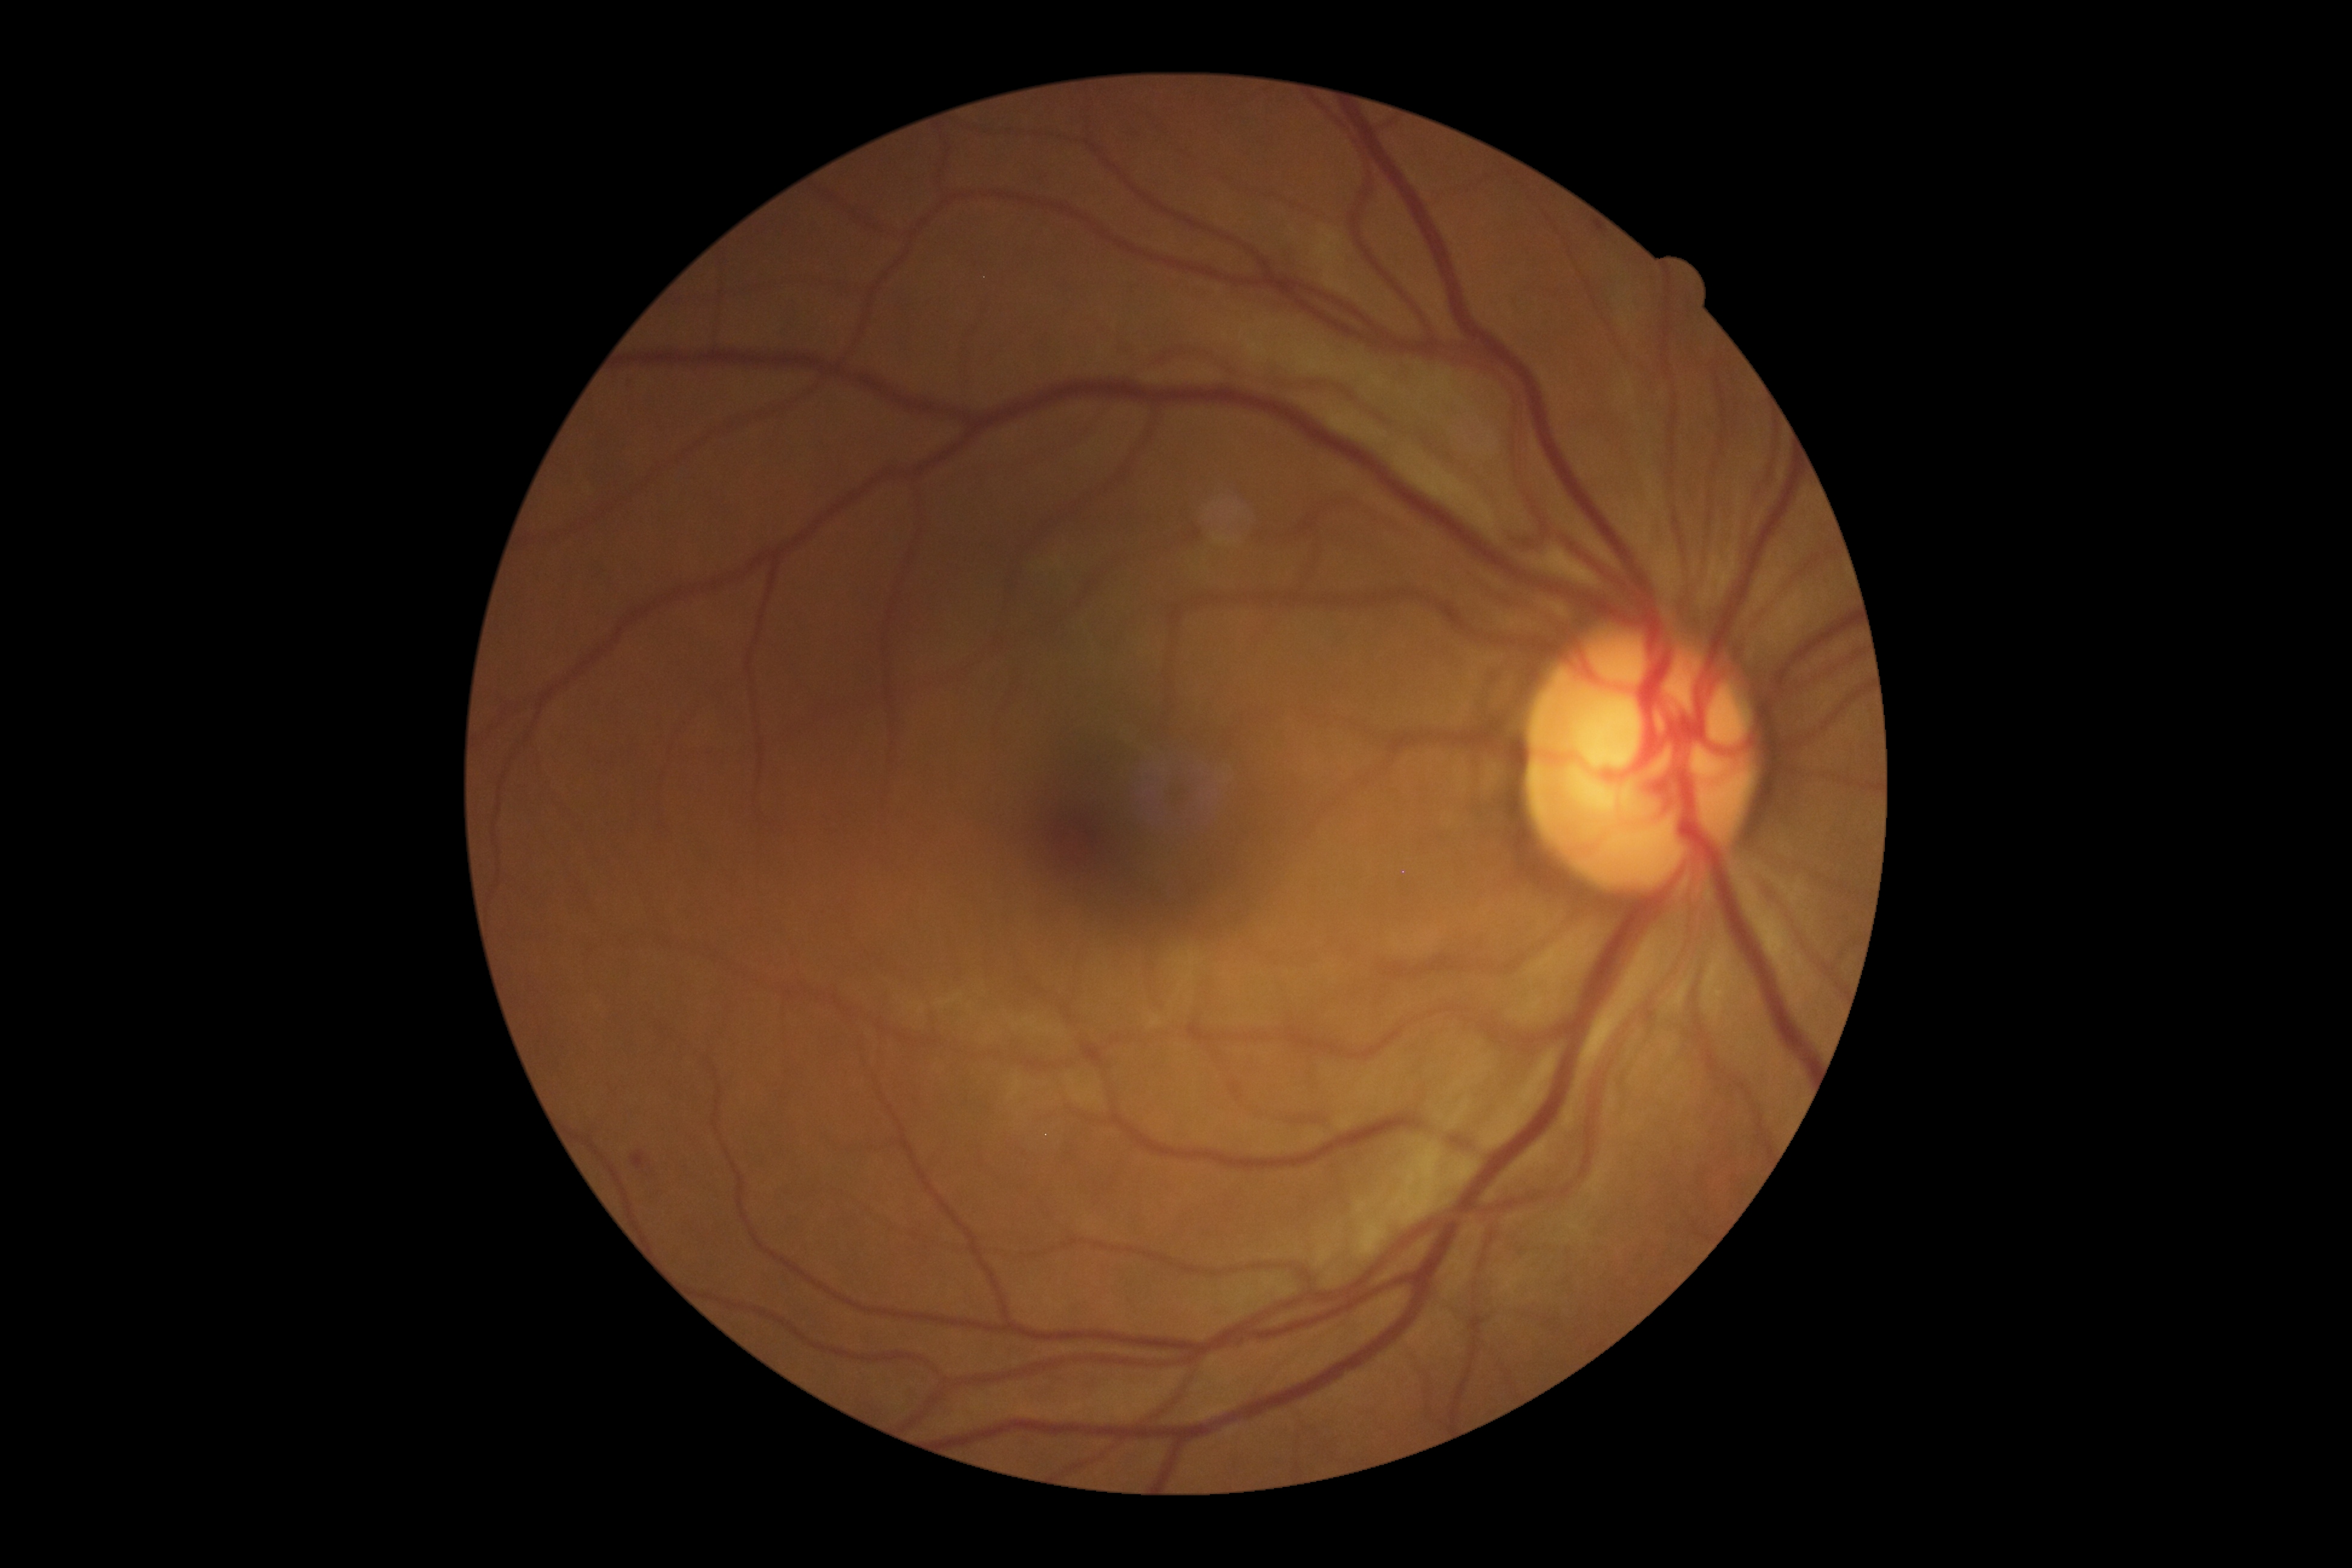 Findings:
– diabetic retinopathy grade — moderate non-proliferative diabetic retinopathy (2)